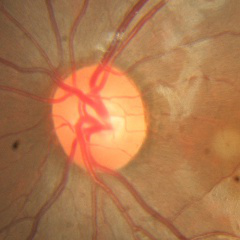 The image shows no glaucomatous findings.